CFP:
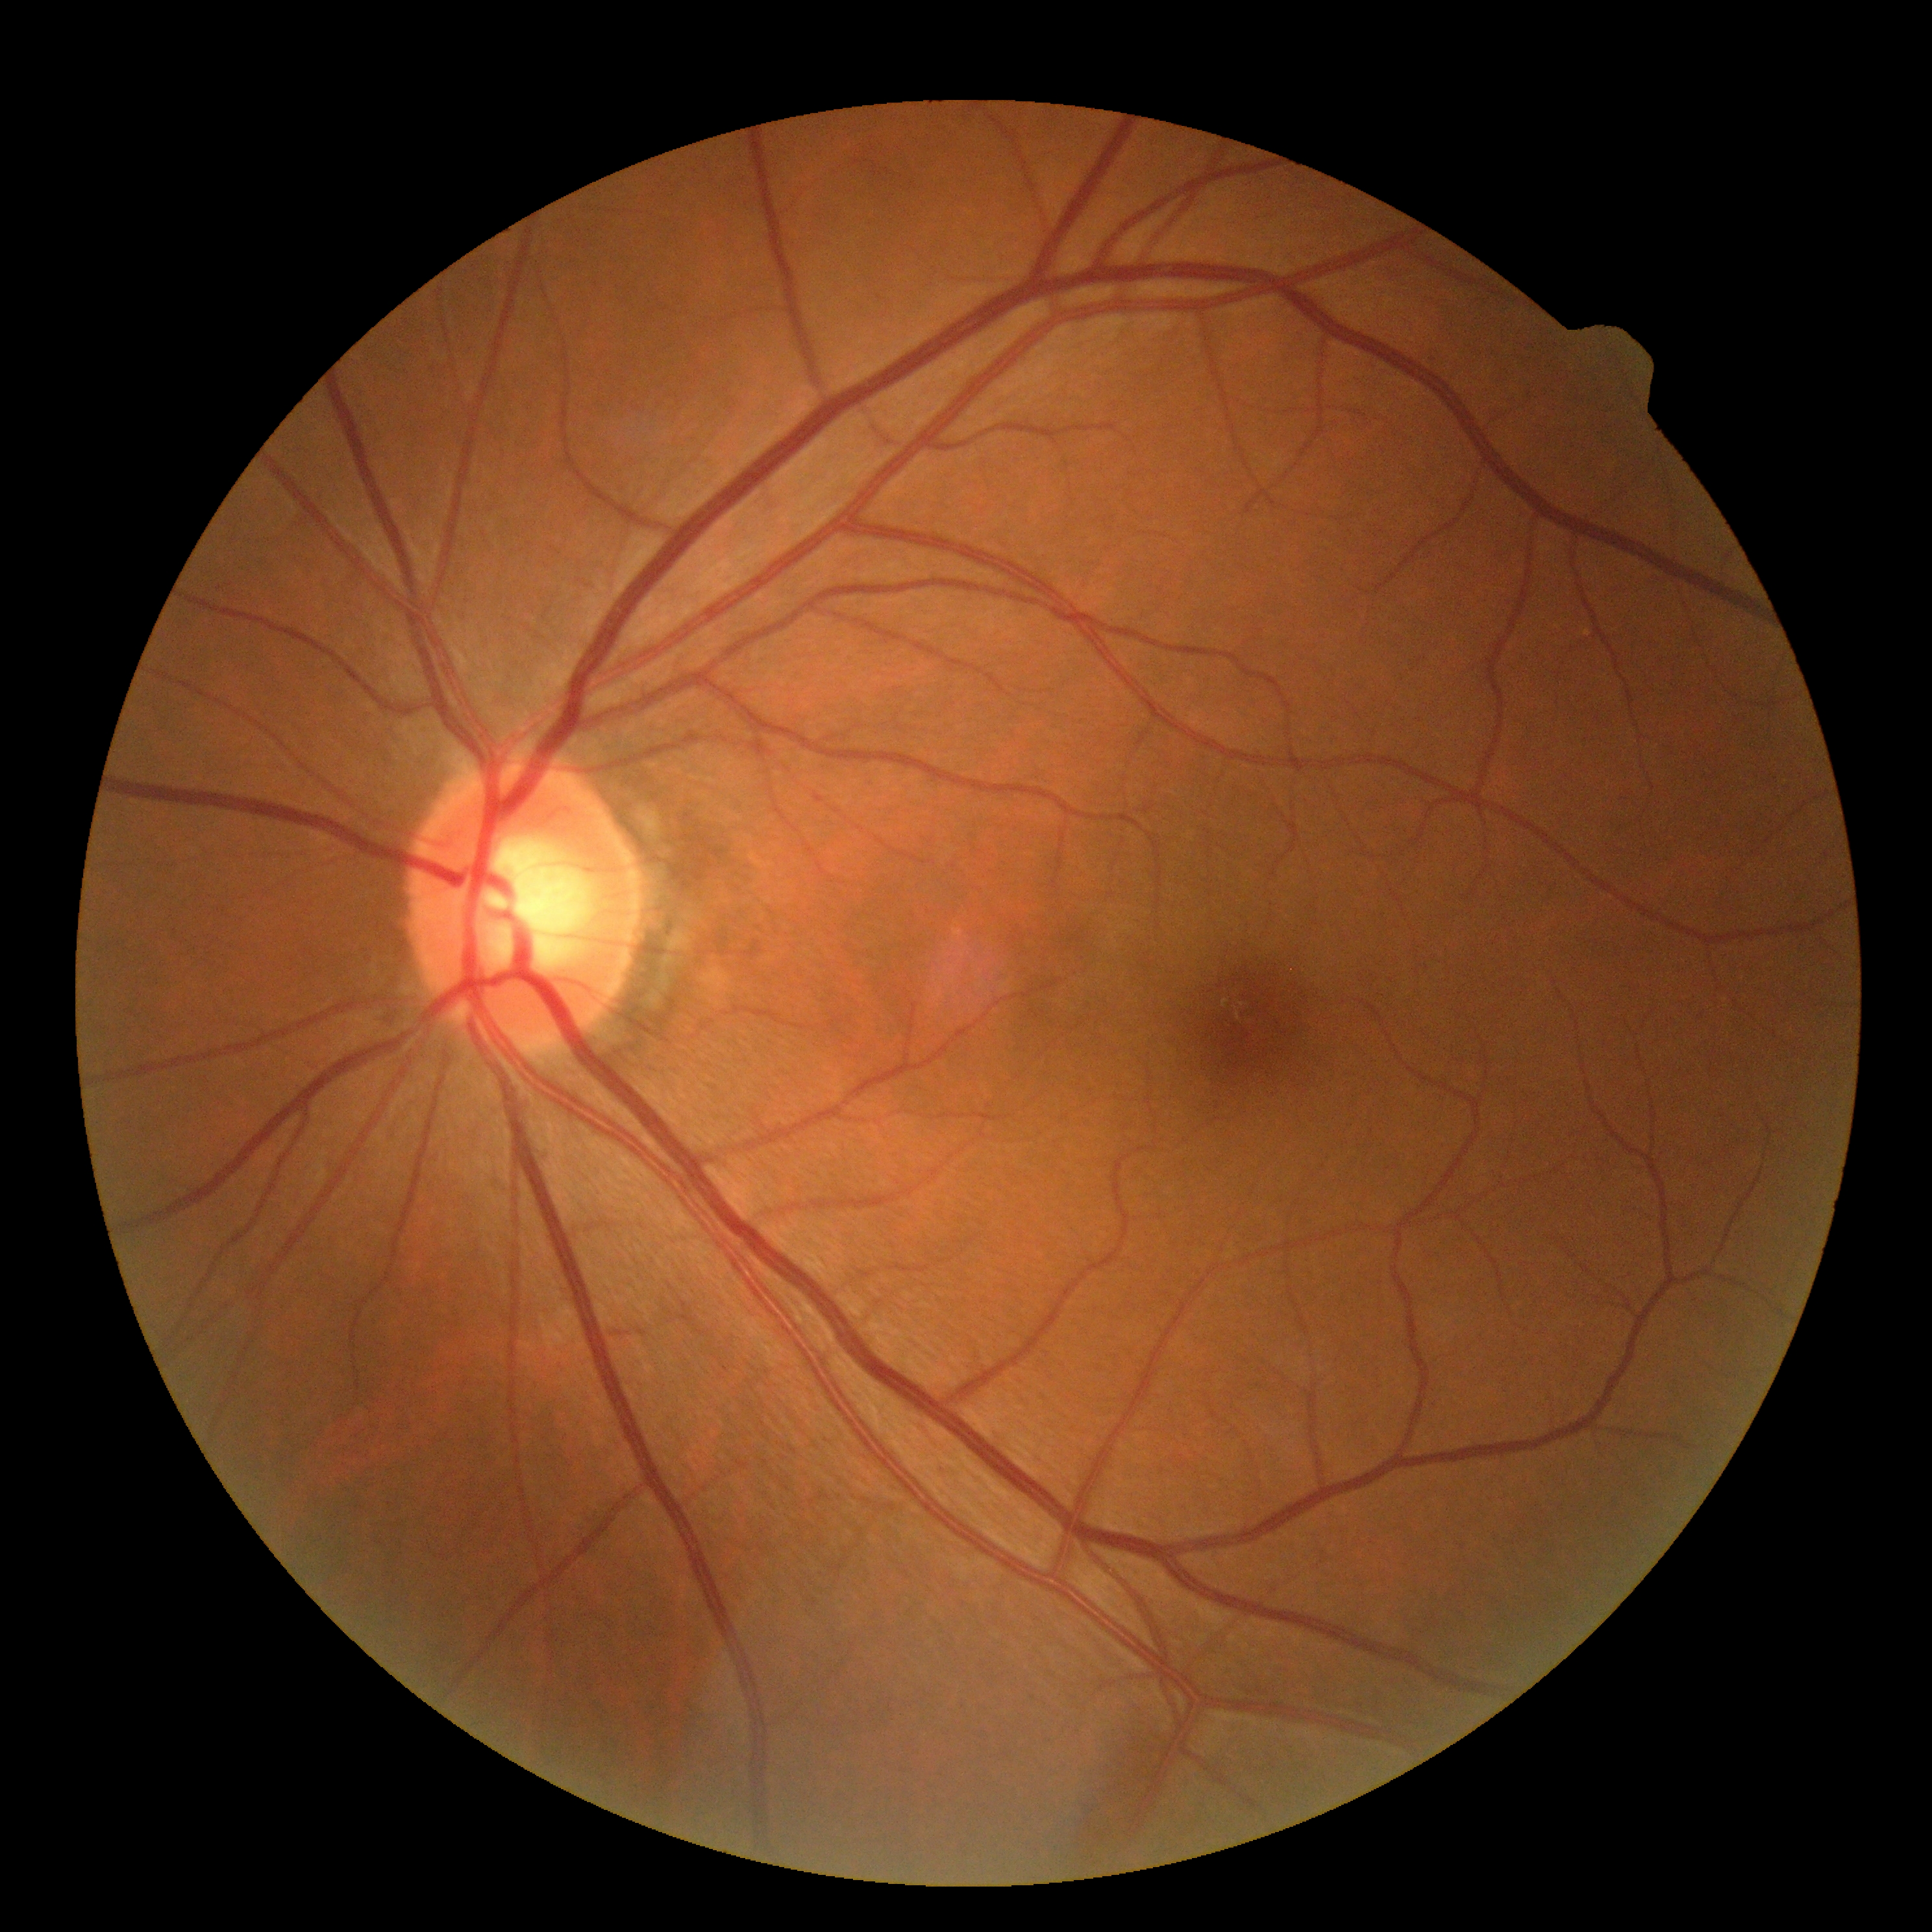
Diabetic retinopathy severity: grade 0 — no visible signs of diabetic retinopathy.